848 by 848 pixels.
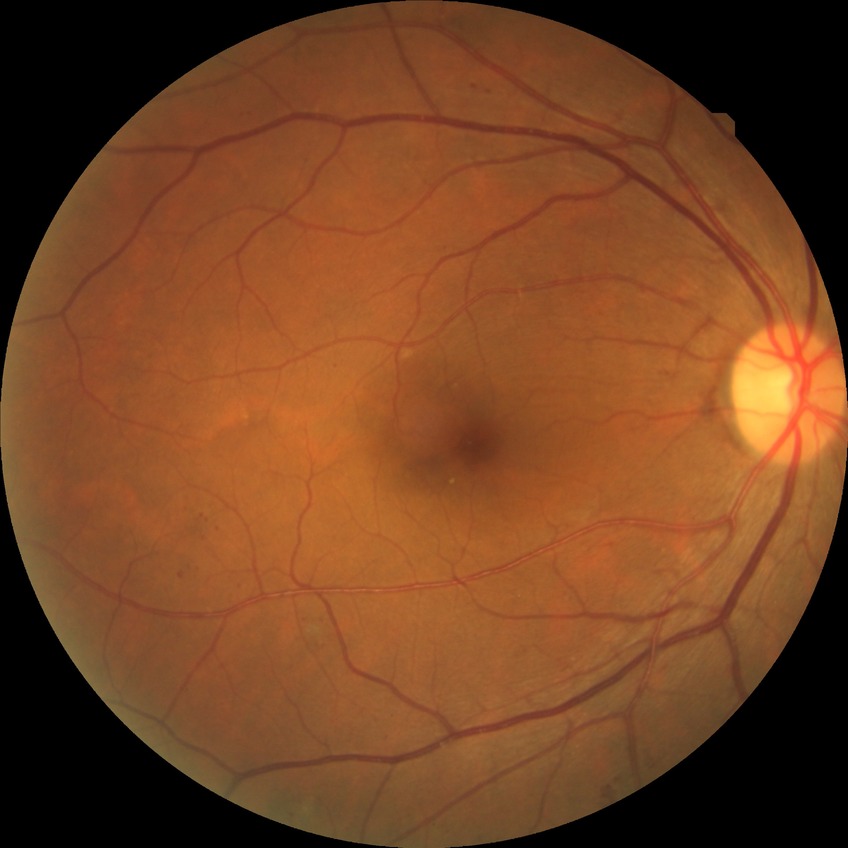   davis_grade: SDR (simple diabetic retinopathy)
  proliferative_class: non-proliferative diabetic retinopathy